Ultra-widefield fundus mosaic:
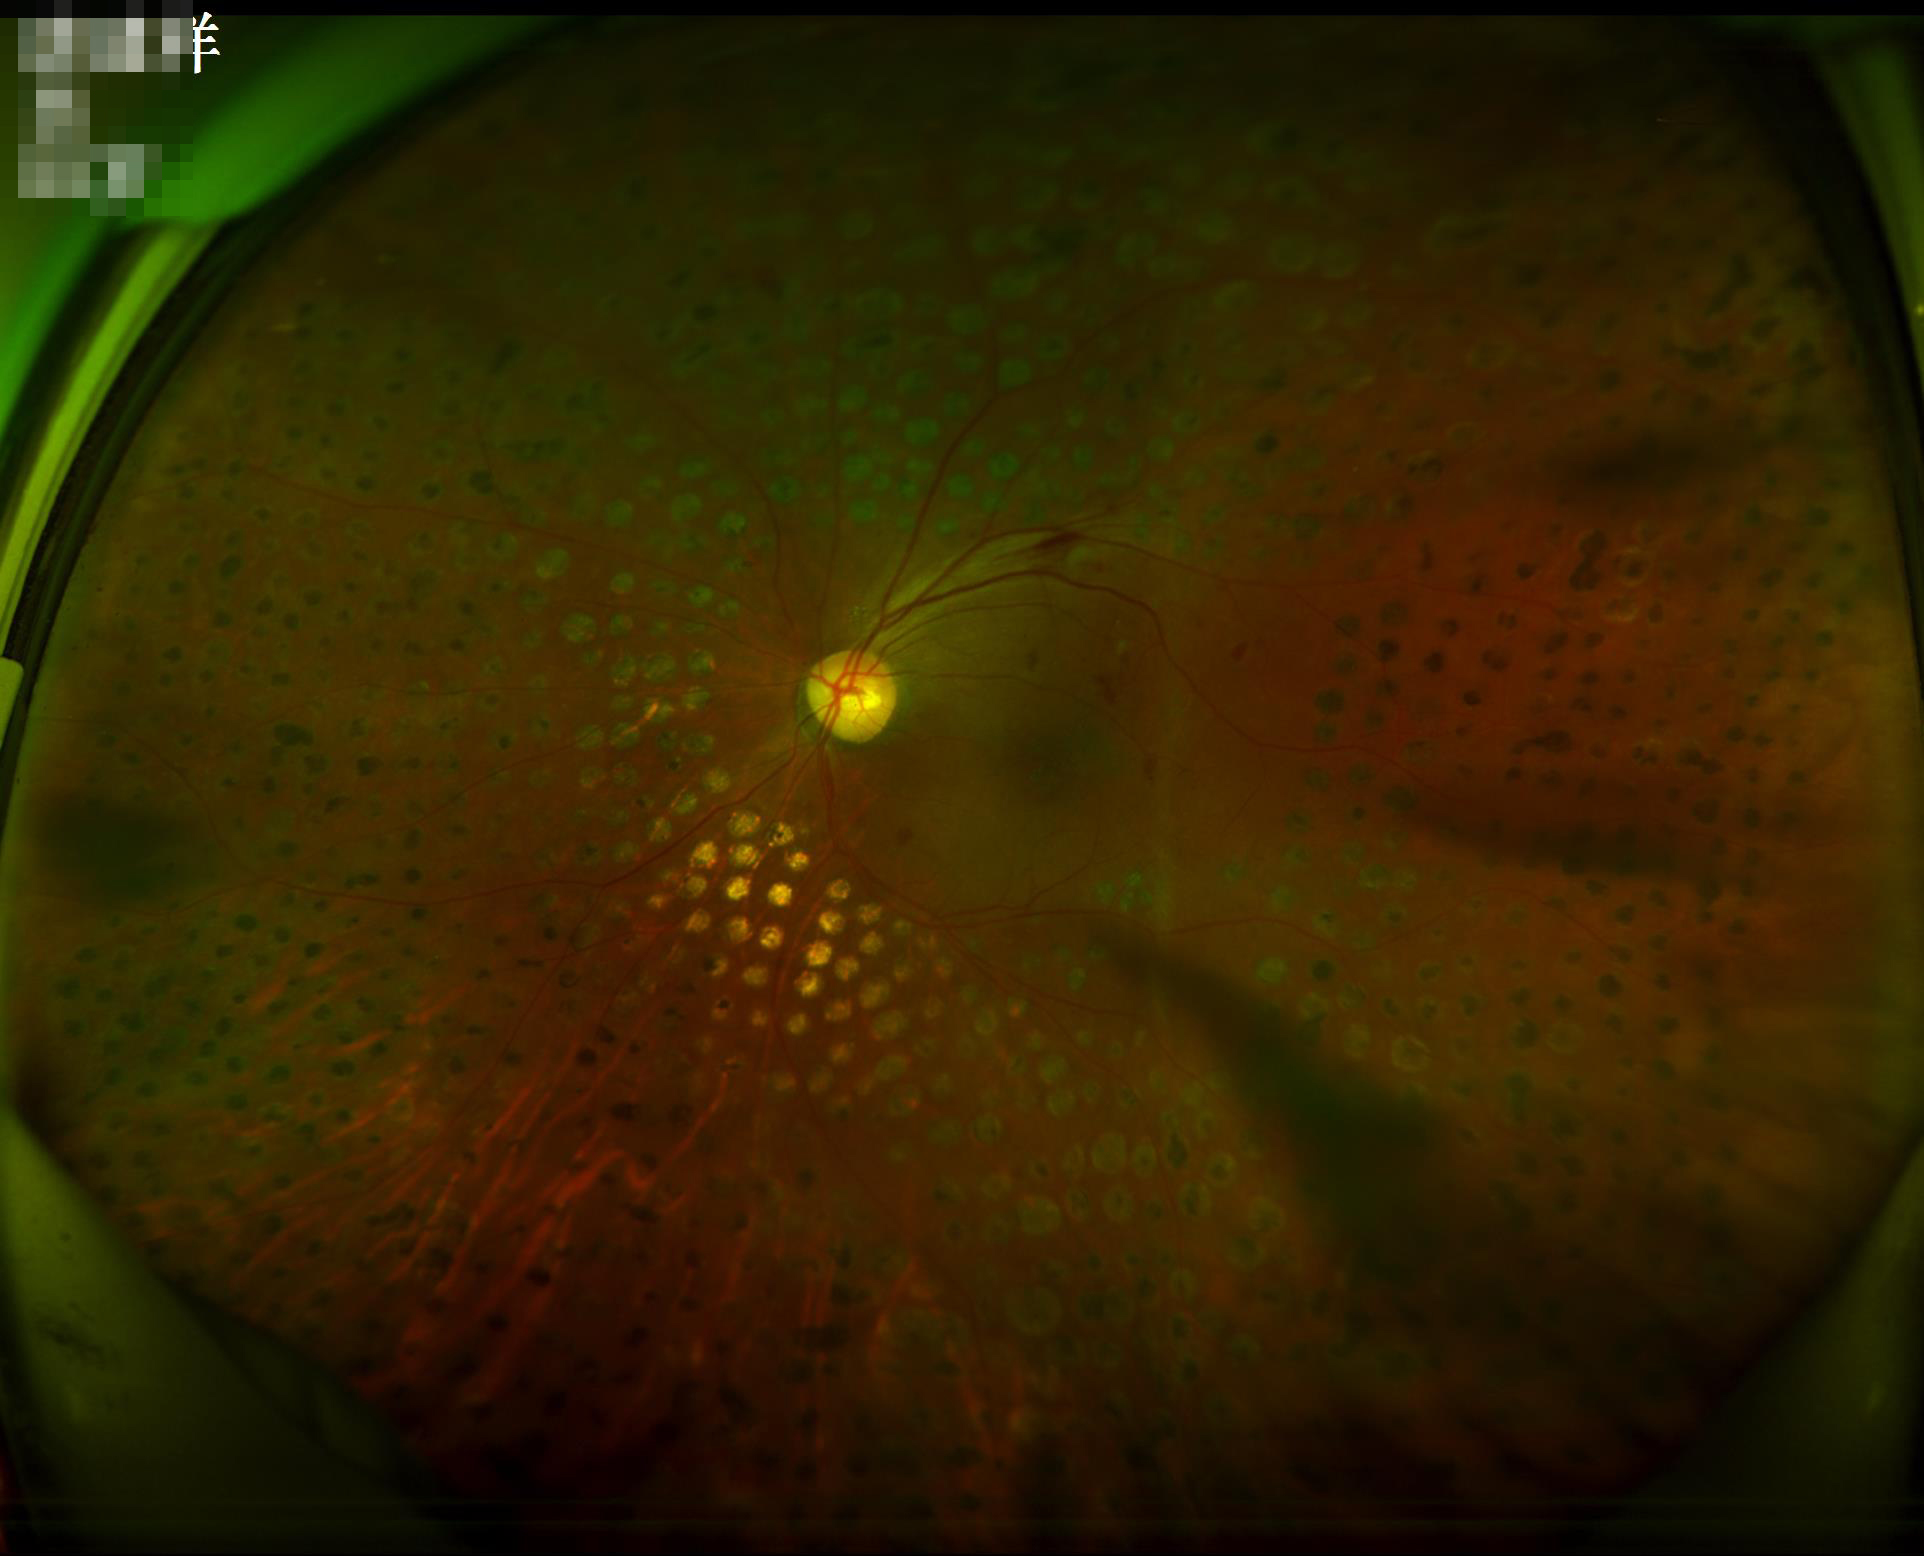
Poor illumination with uneven exposure. Good dynamic range. Noticeable blur in the optic disc, vessels, or background. Overall image quality is good.